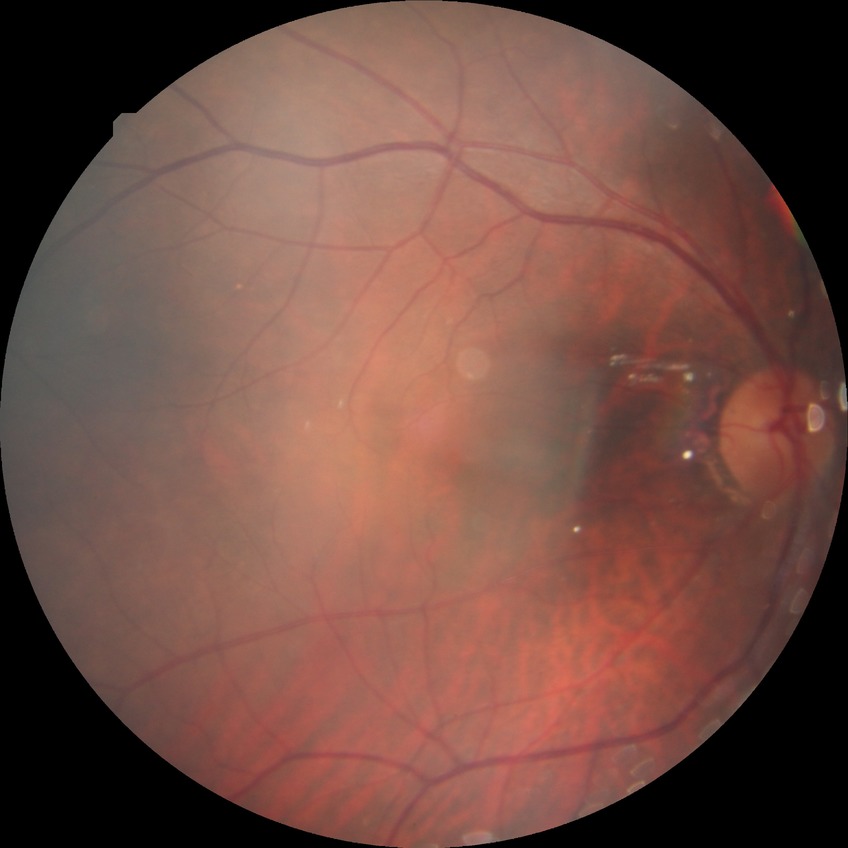

No diabetic retinal disease findings. DR is NDR.